Modified Davis classification
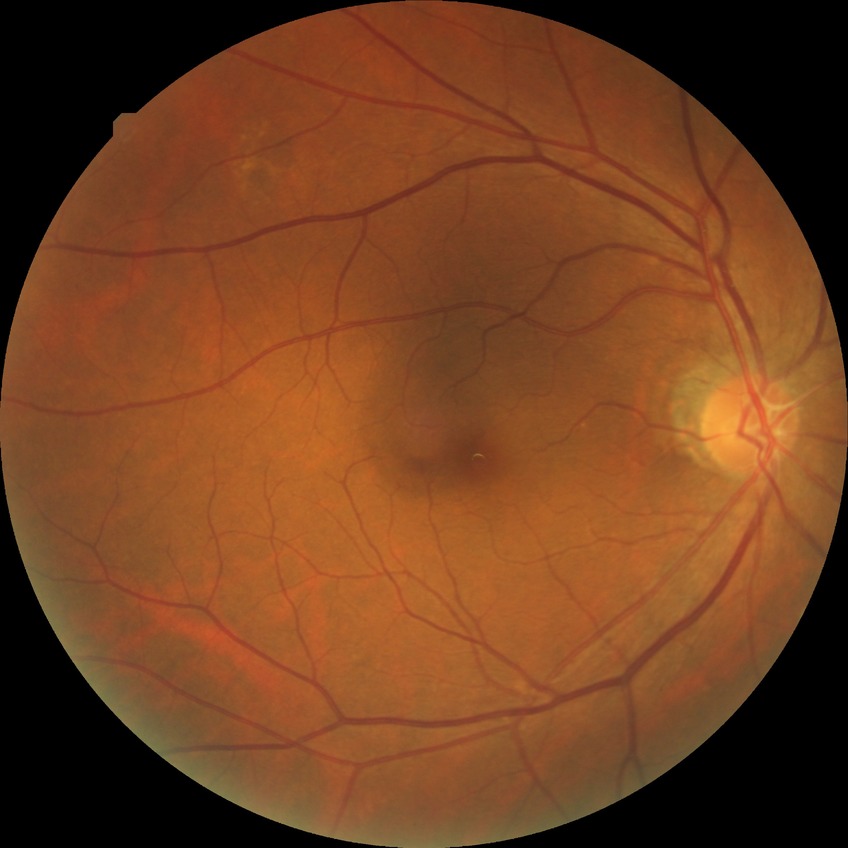
davis_grade: no diabetic retinopathy (NDR)